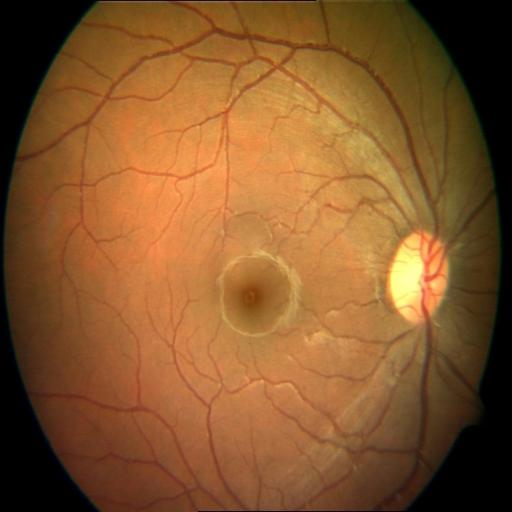
Diagnoses: central serous retinopathy (CSR).